RetCam wide-field infant fundus image — 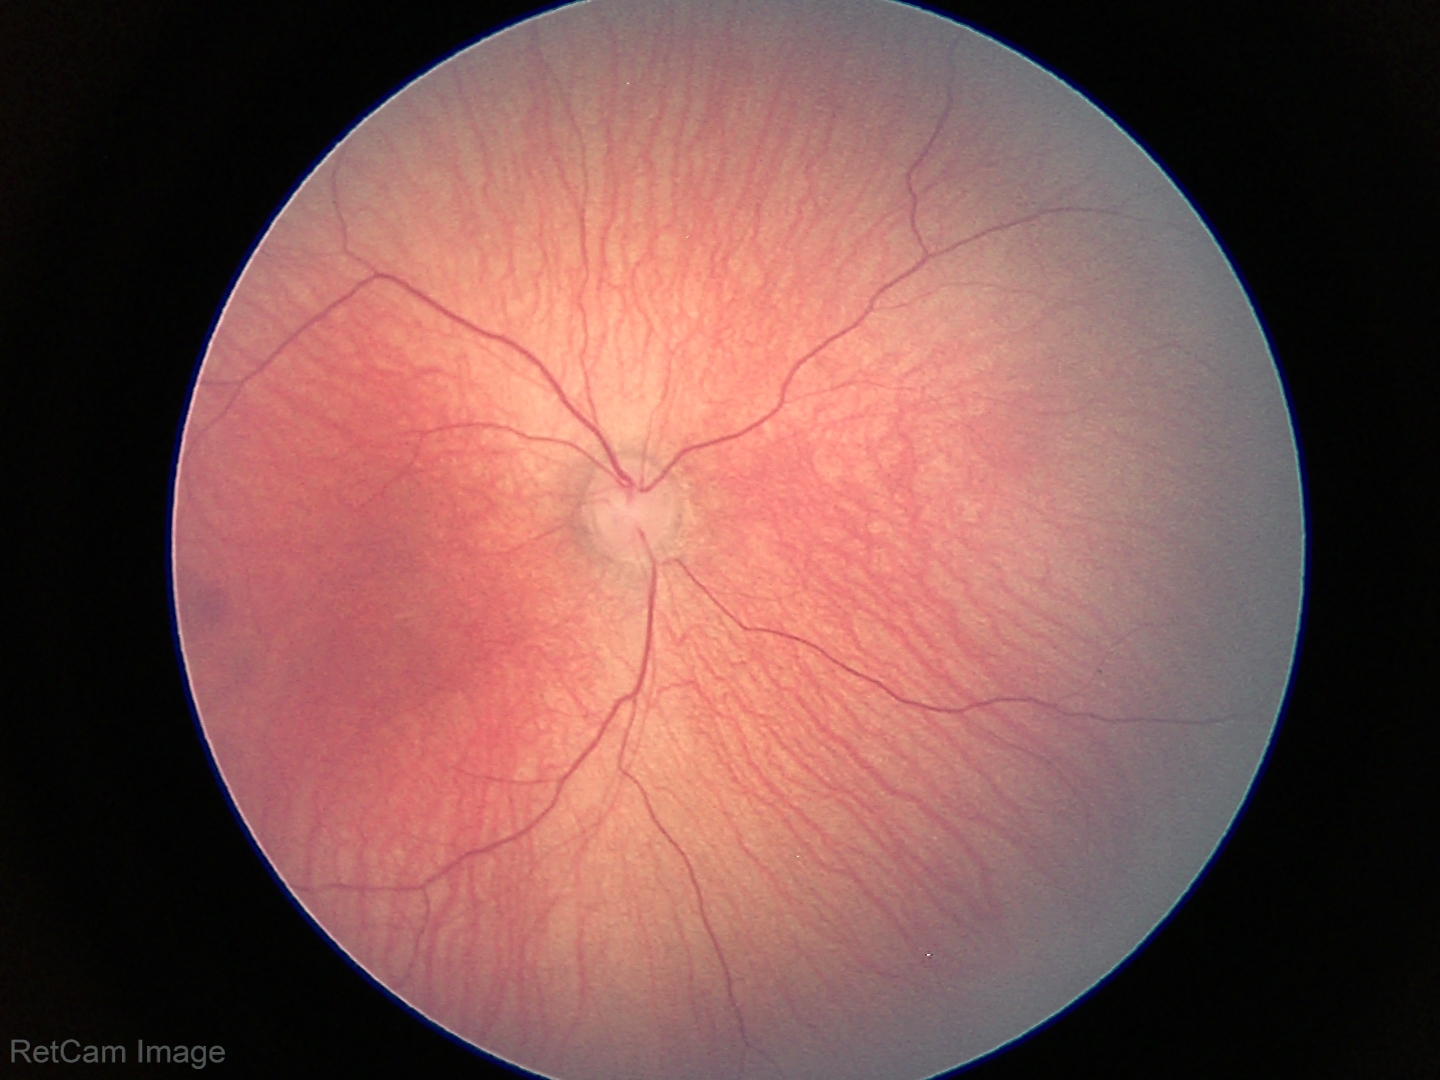

Diagnosis: normal retinal appearance.